NIDEK AFC-230 fundus camera:
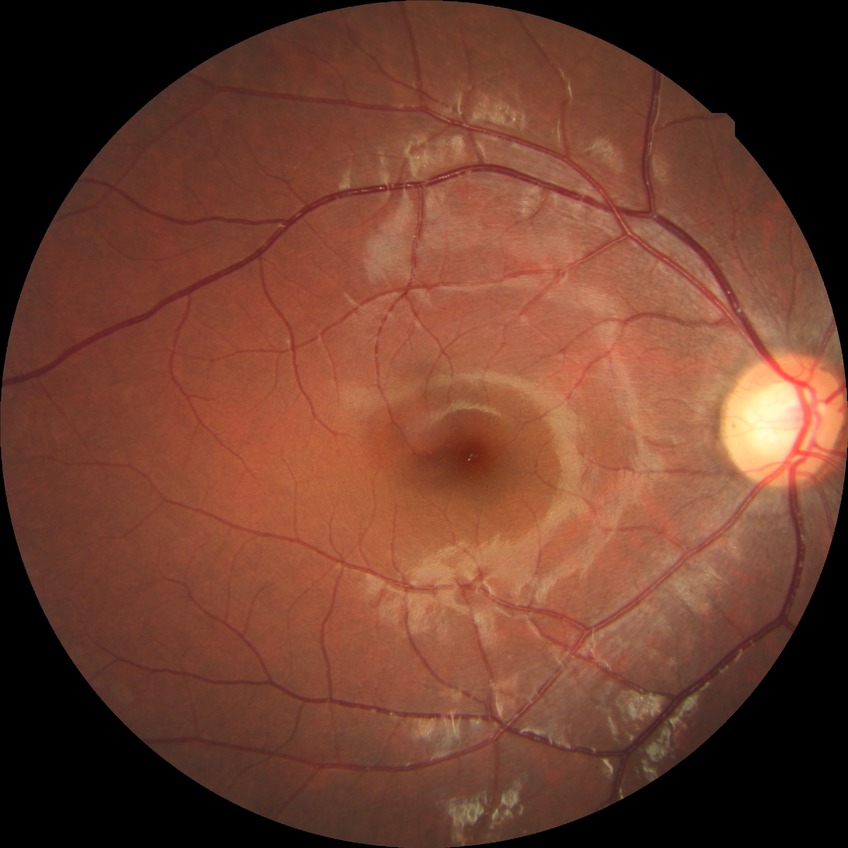 diabetic retinopathy (DR): NDR (no diabetic retinopathy).